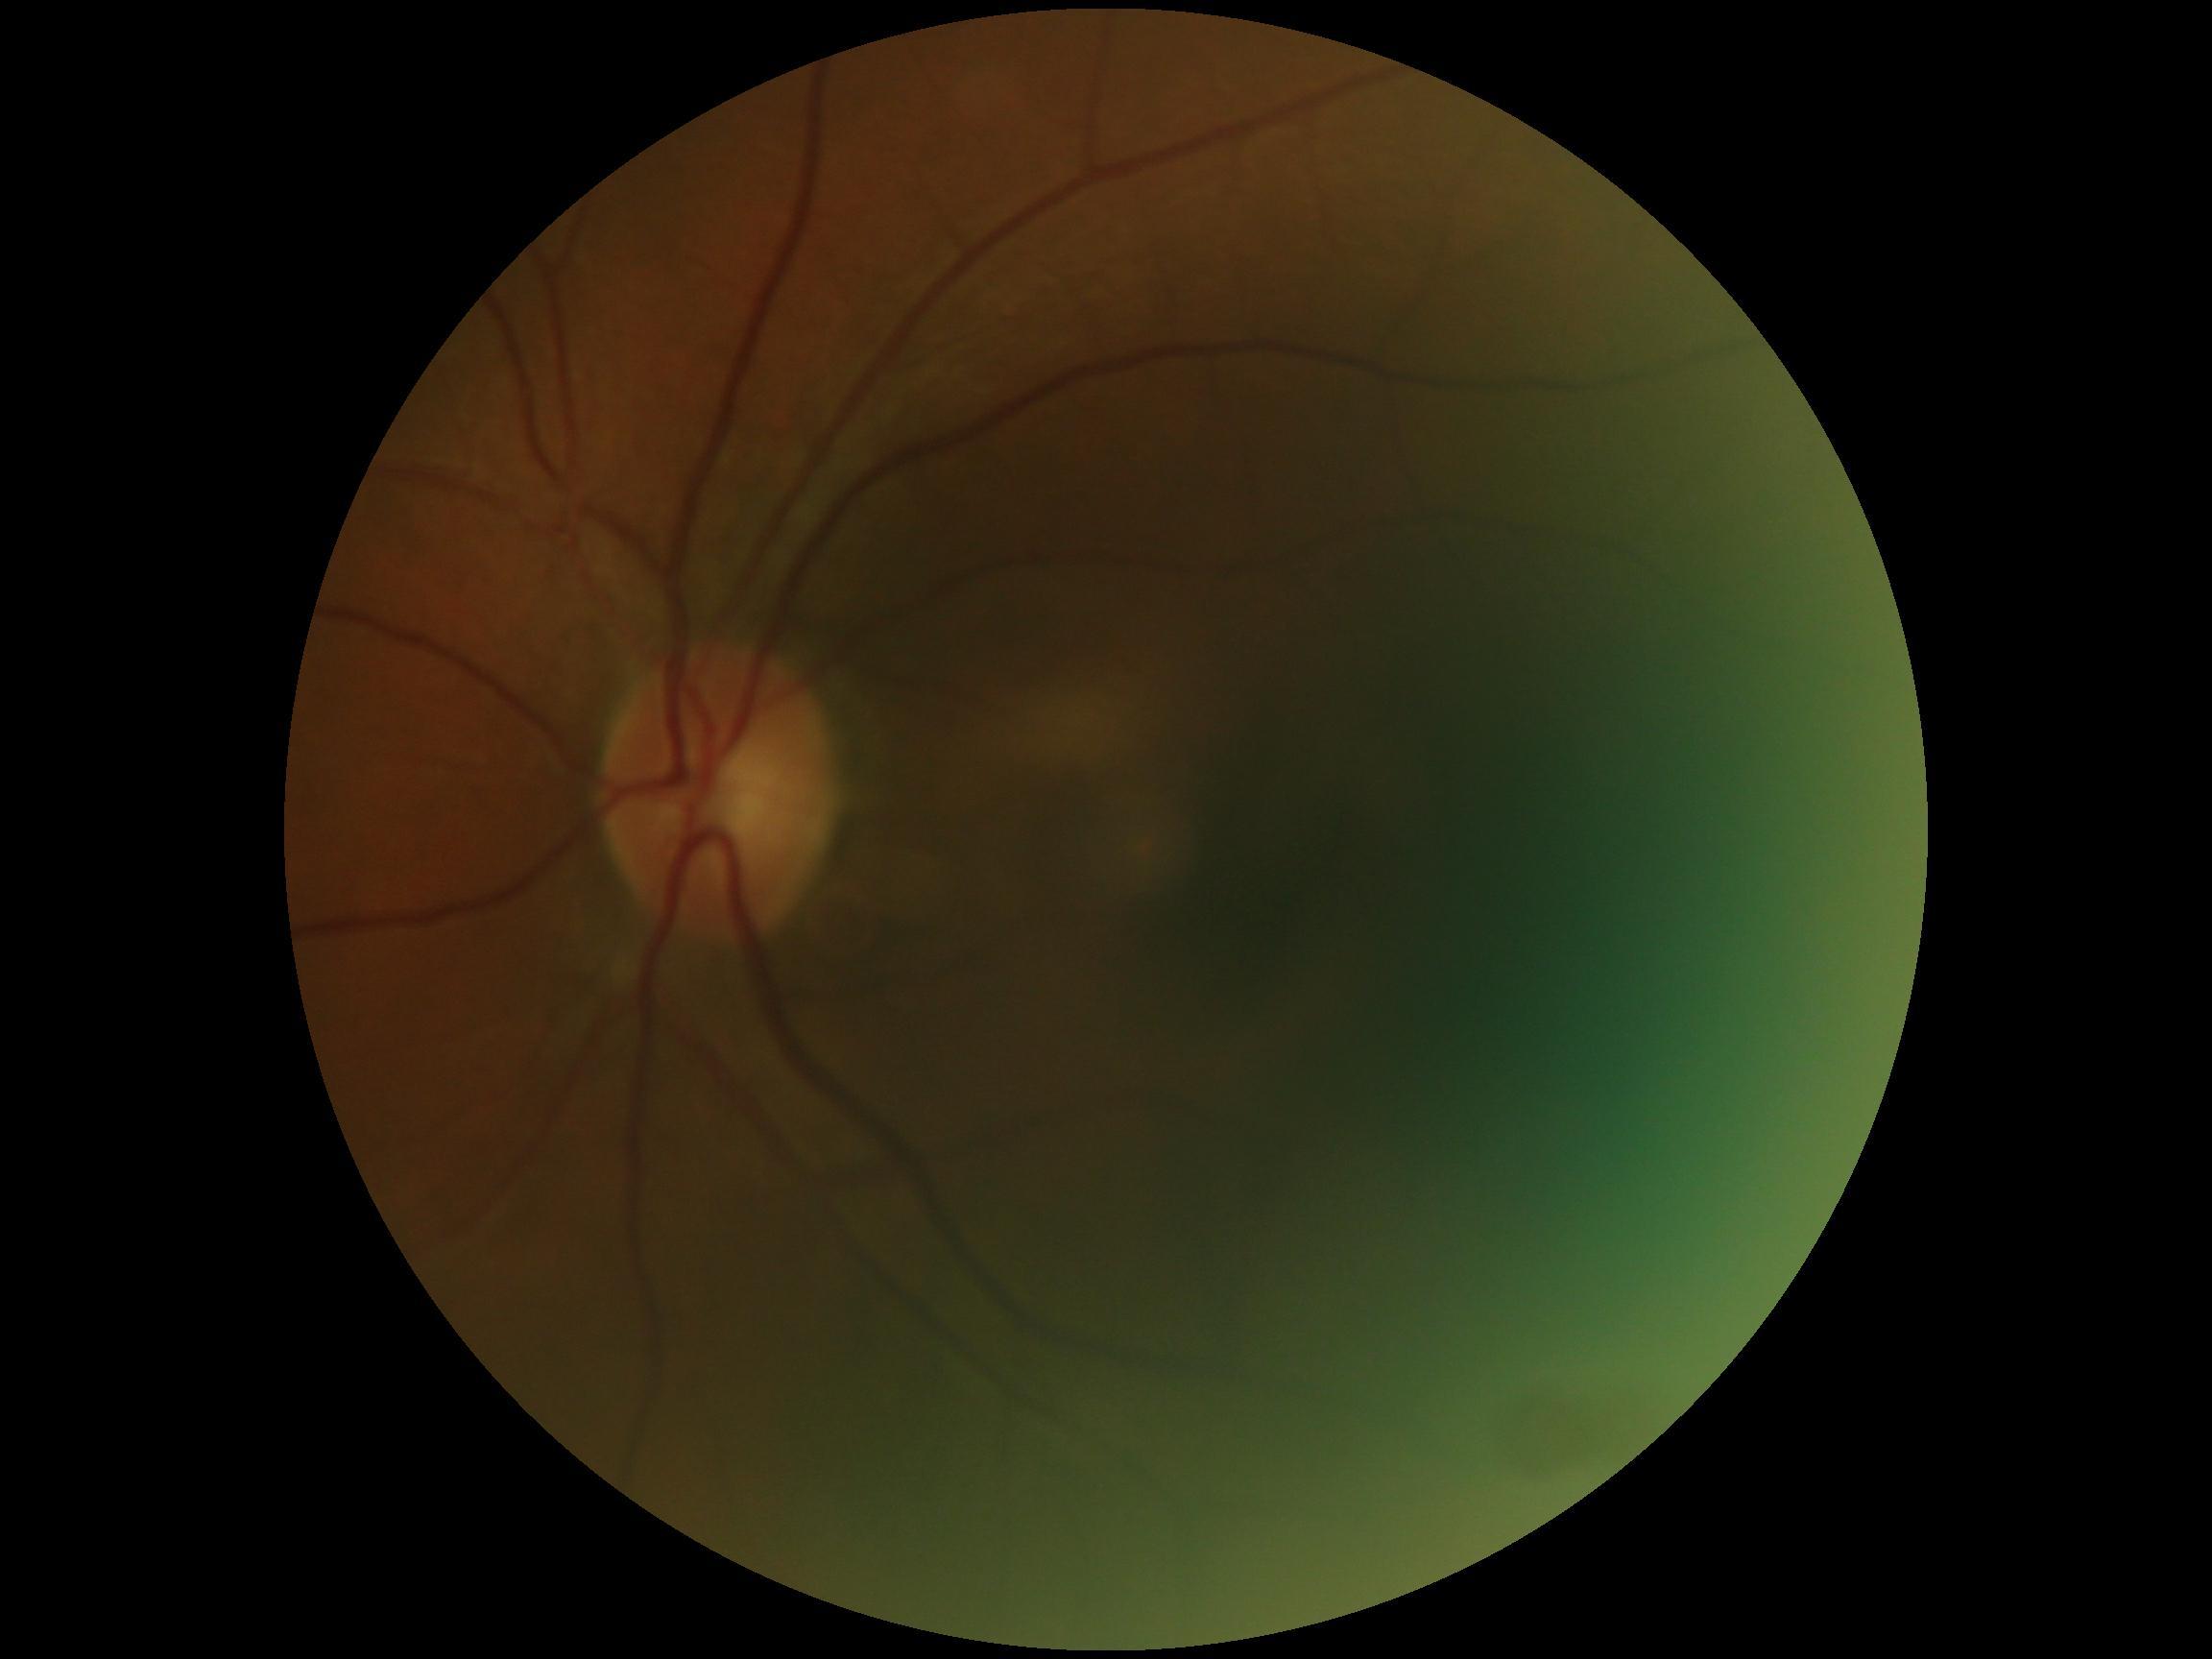 DR stage: 0/4.